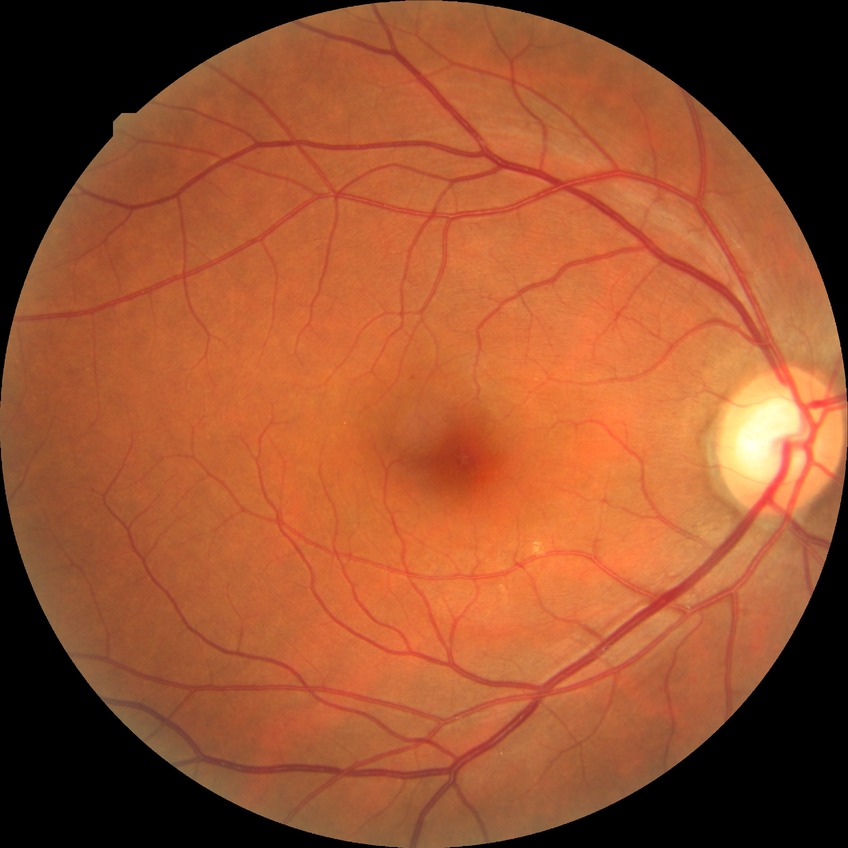 – DR class — non-proliferative diabetic retinopathy
– diabetic retinopathy stage — simple diabetic retinopathy